Graded on the modified Davis scale.
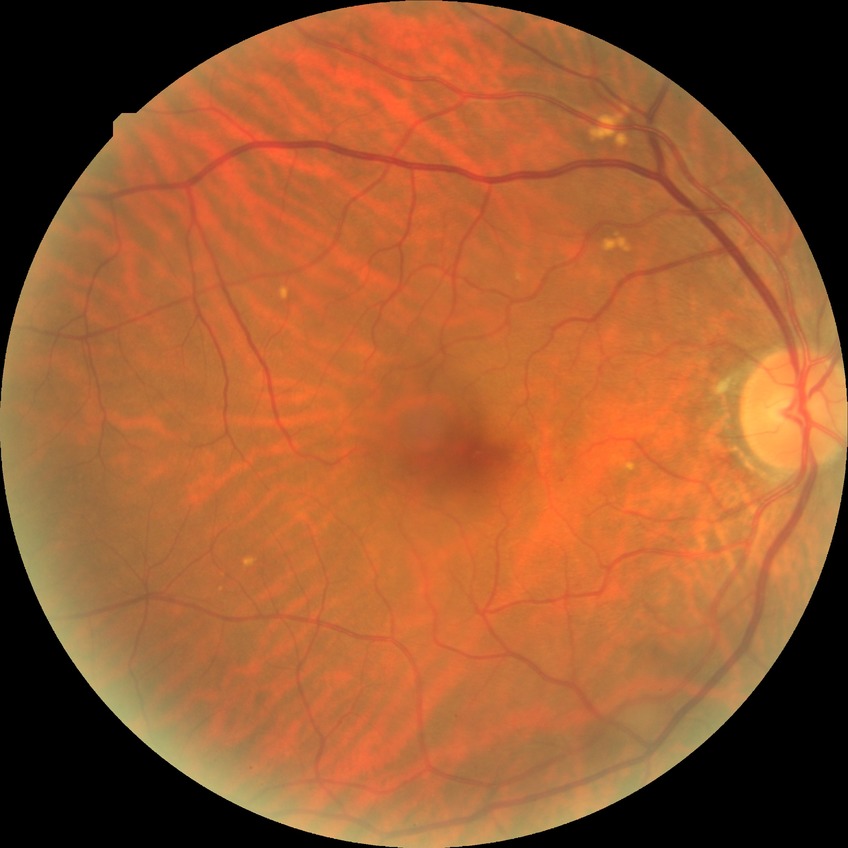

Diabetic retinopathy (DR): no diabetic retinopathy (NDR).